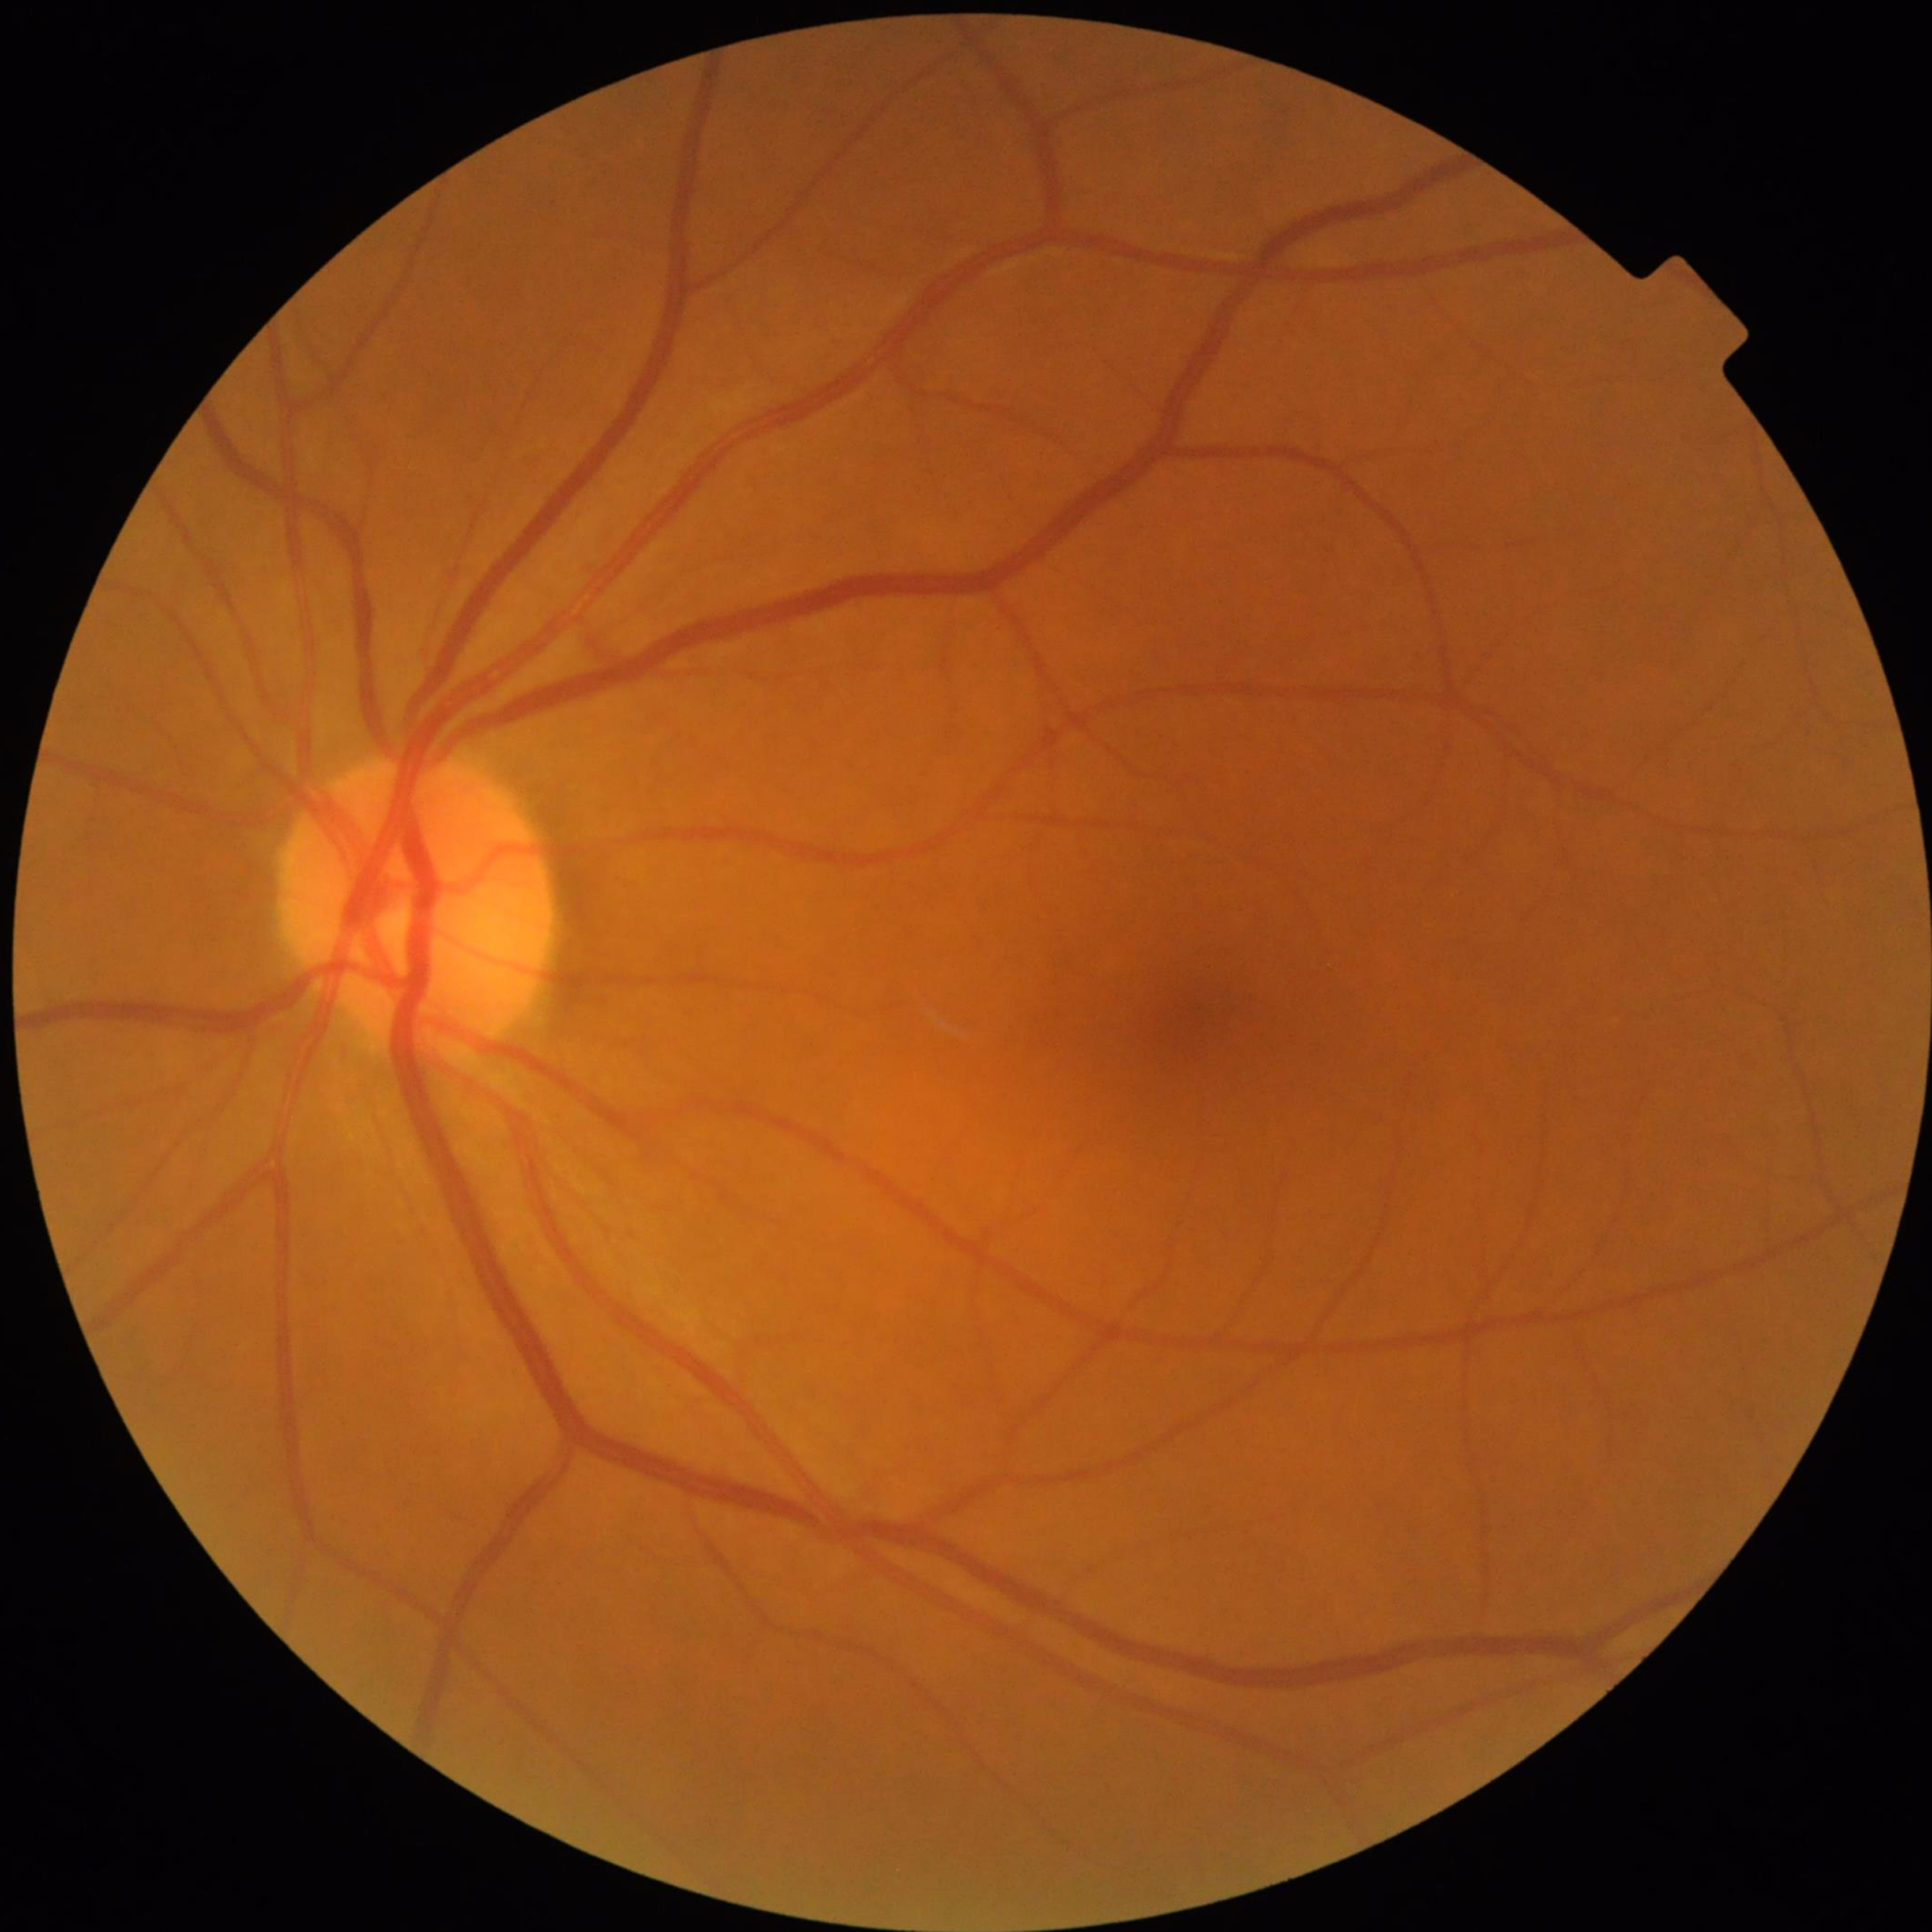
No findings of AMD, diabetic retinopathy, or glaucoma.